Color fundus photograph:
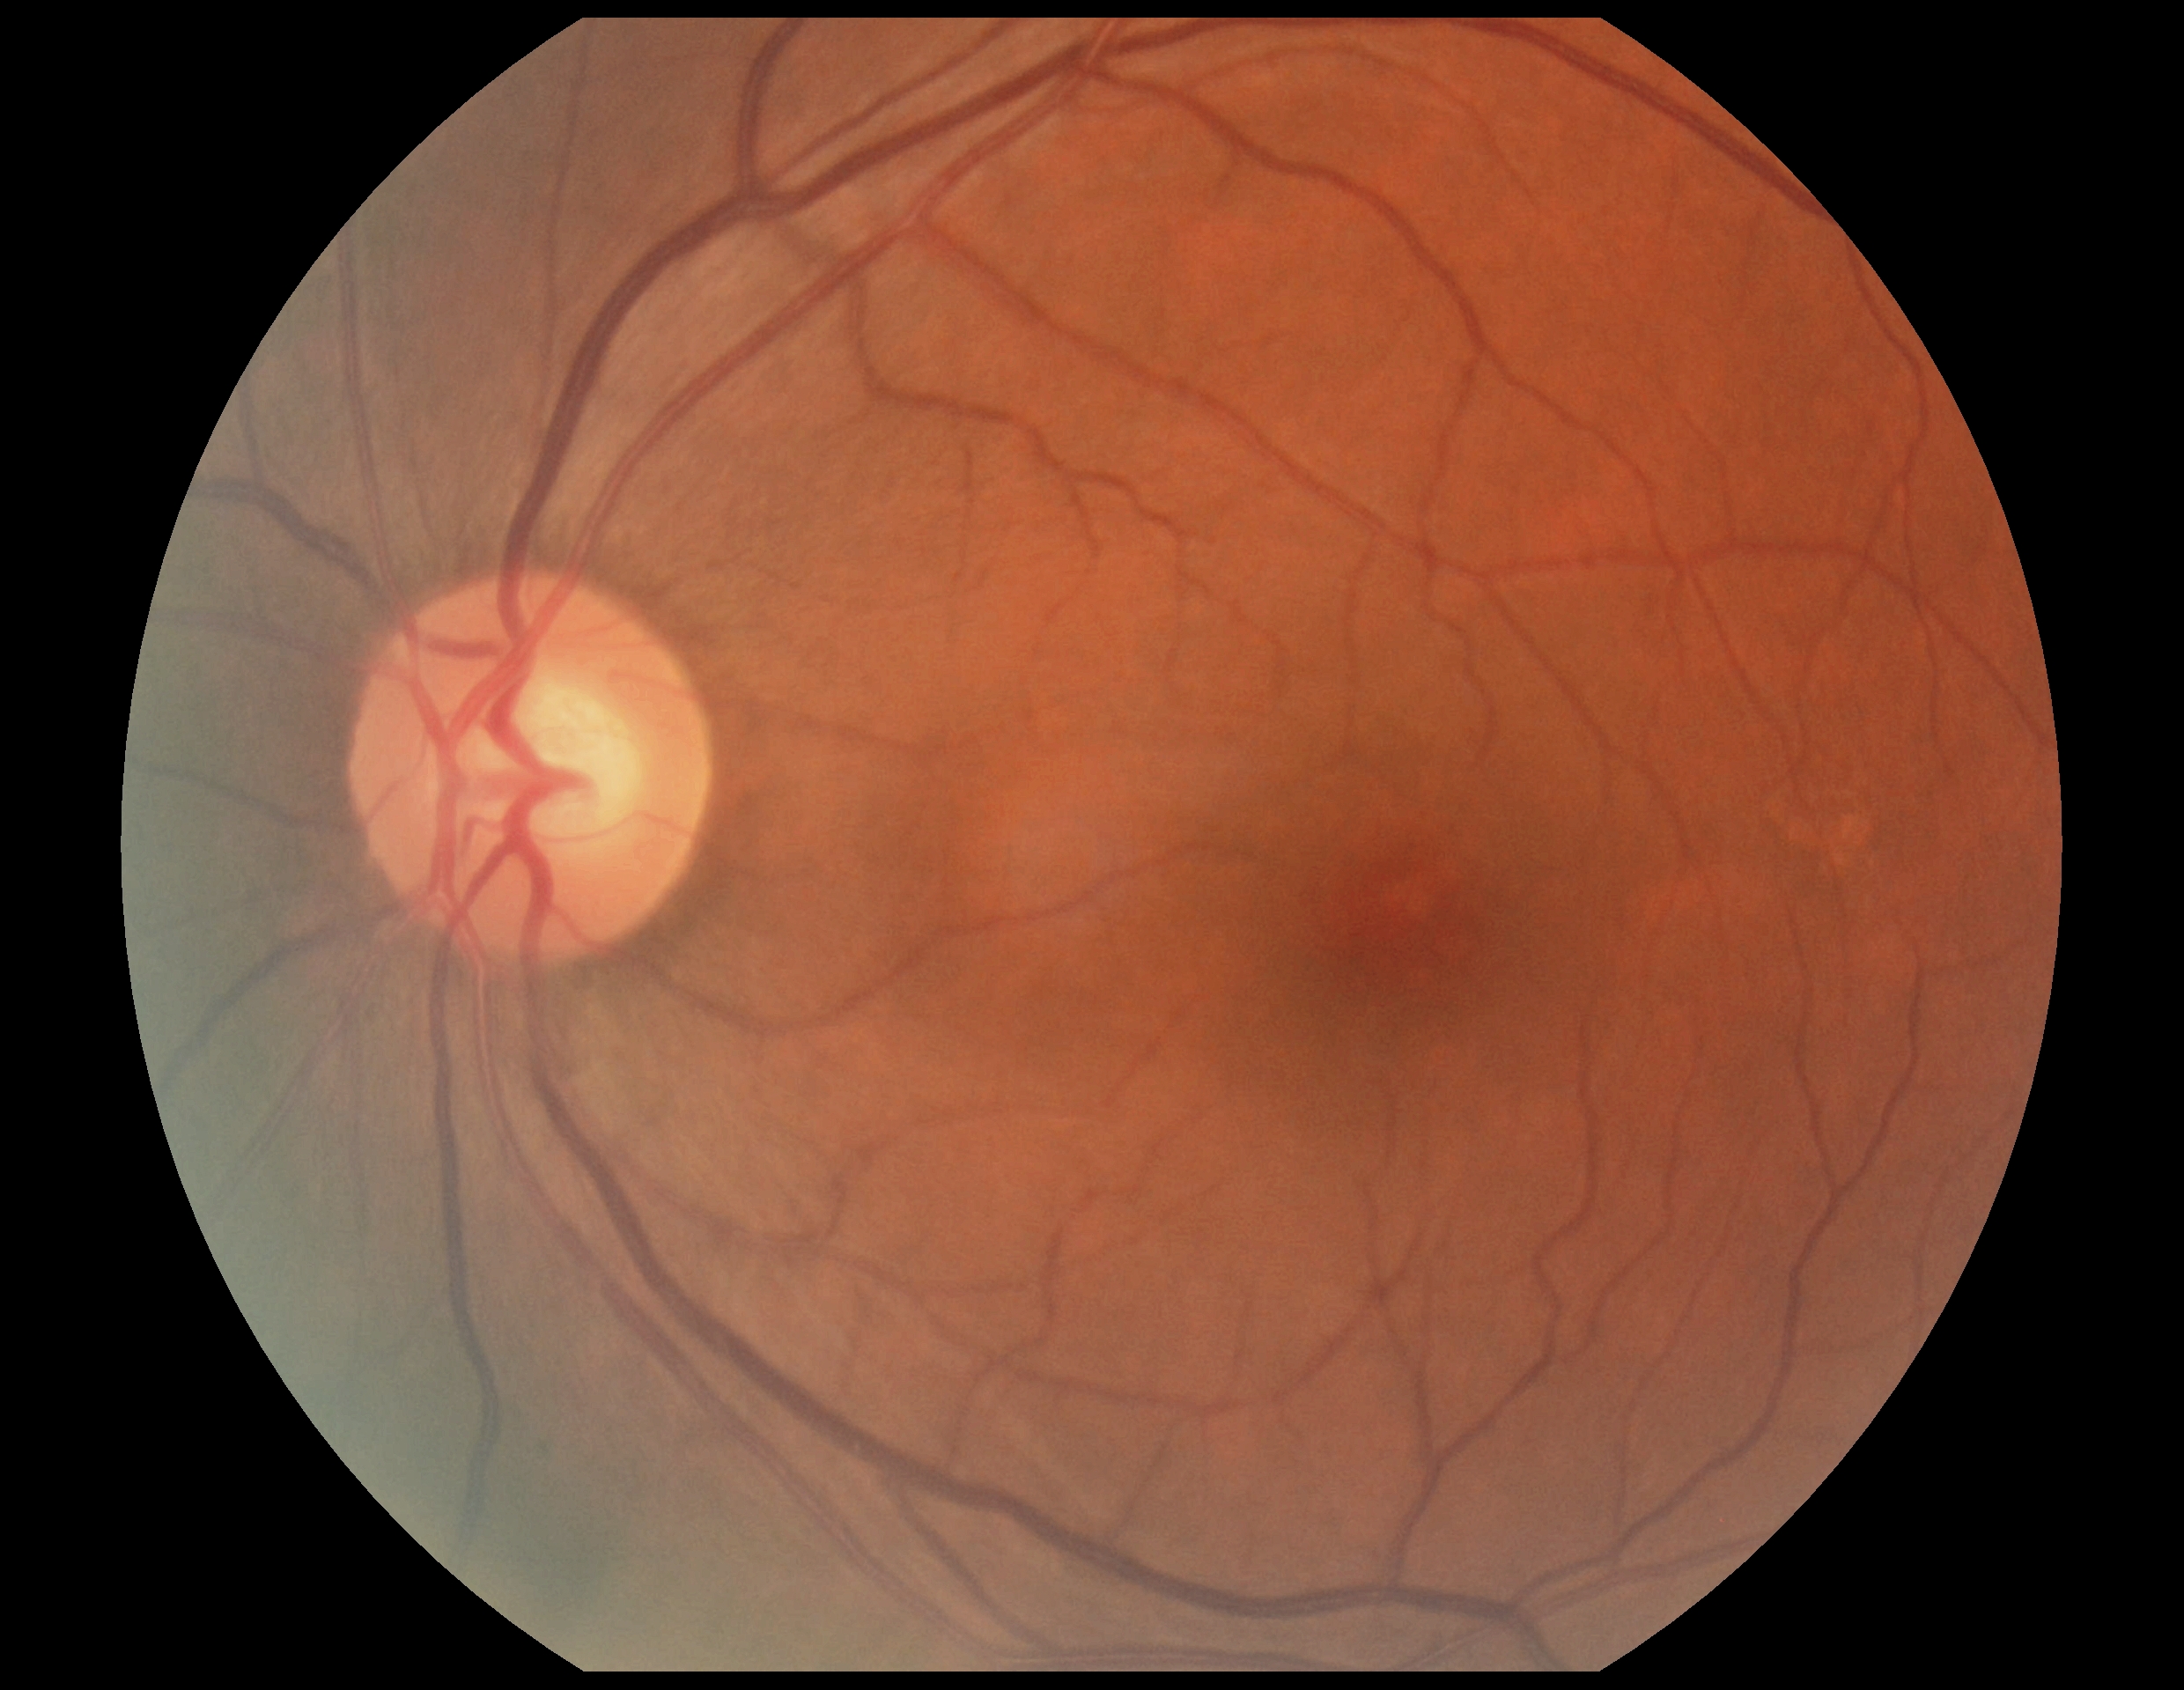 DR stage is no apparent diabetic retinopathy (grade 0) — no visible signs of diabetic retinopathy.